NIDEK AFC-230 fundus camera · Davis DR grading · color fundus image · no pharmacologic dilation · 848 by 848 pixels:
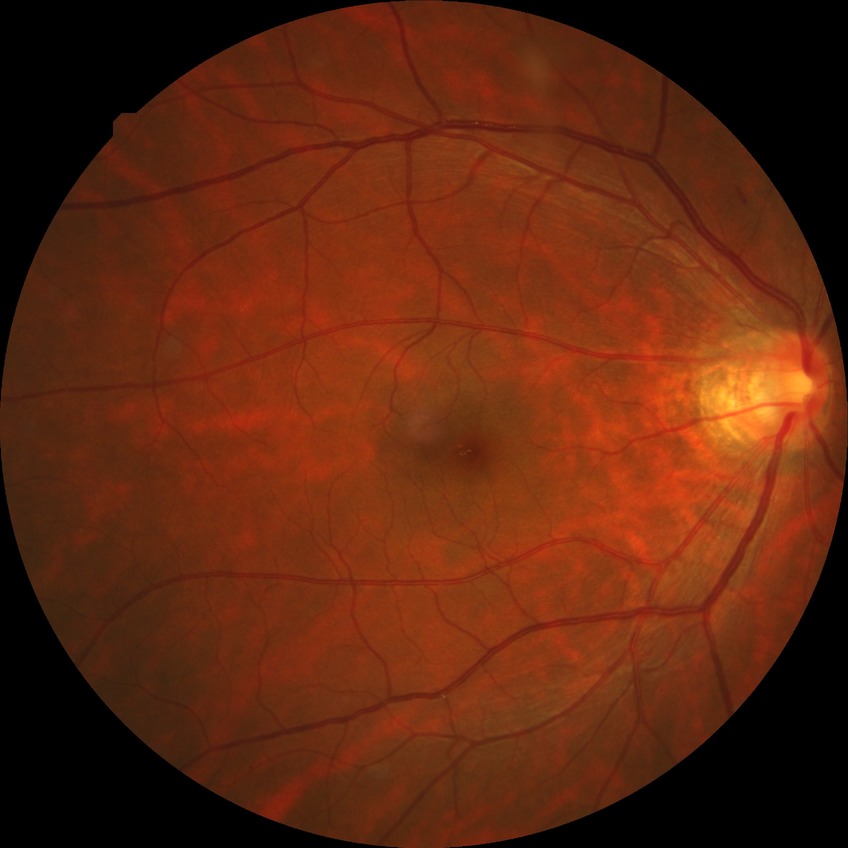

davis_grade: SDR (simple diabetic retinopathy)